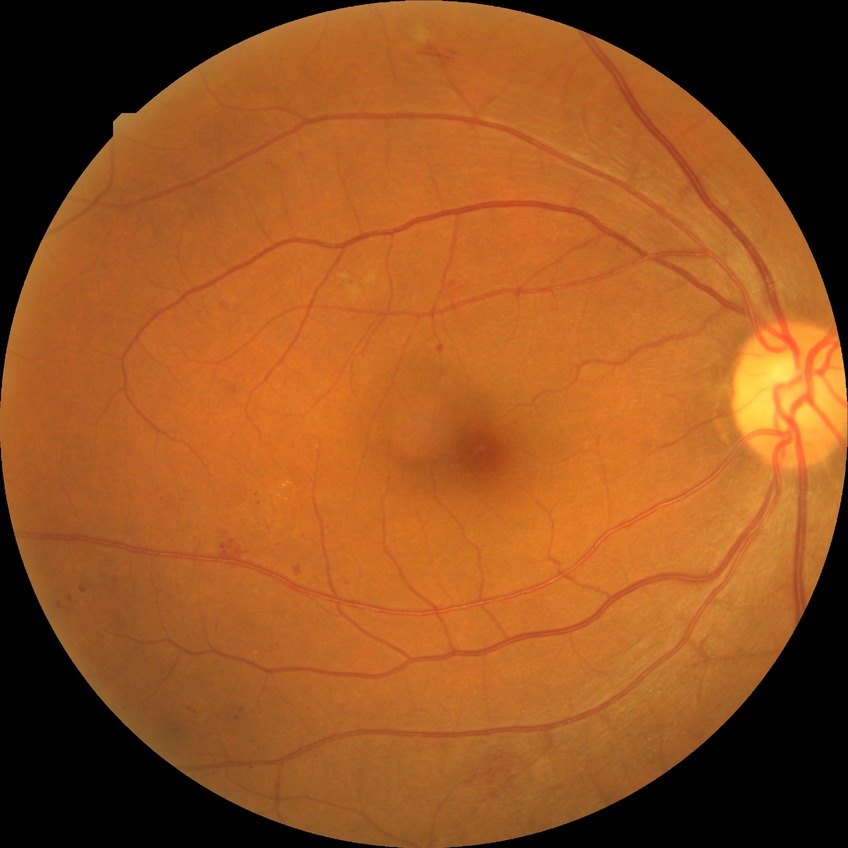

Assessment:
– diabetic retinopathy (DR) — PPDR (pre-proliferative diabetic retinopathy)